Color fundus photograph · 2352x1568px.
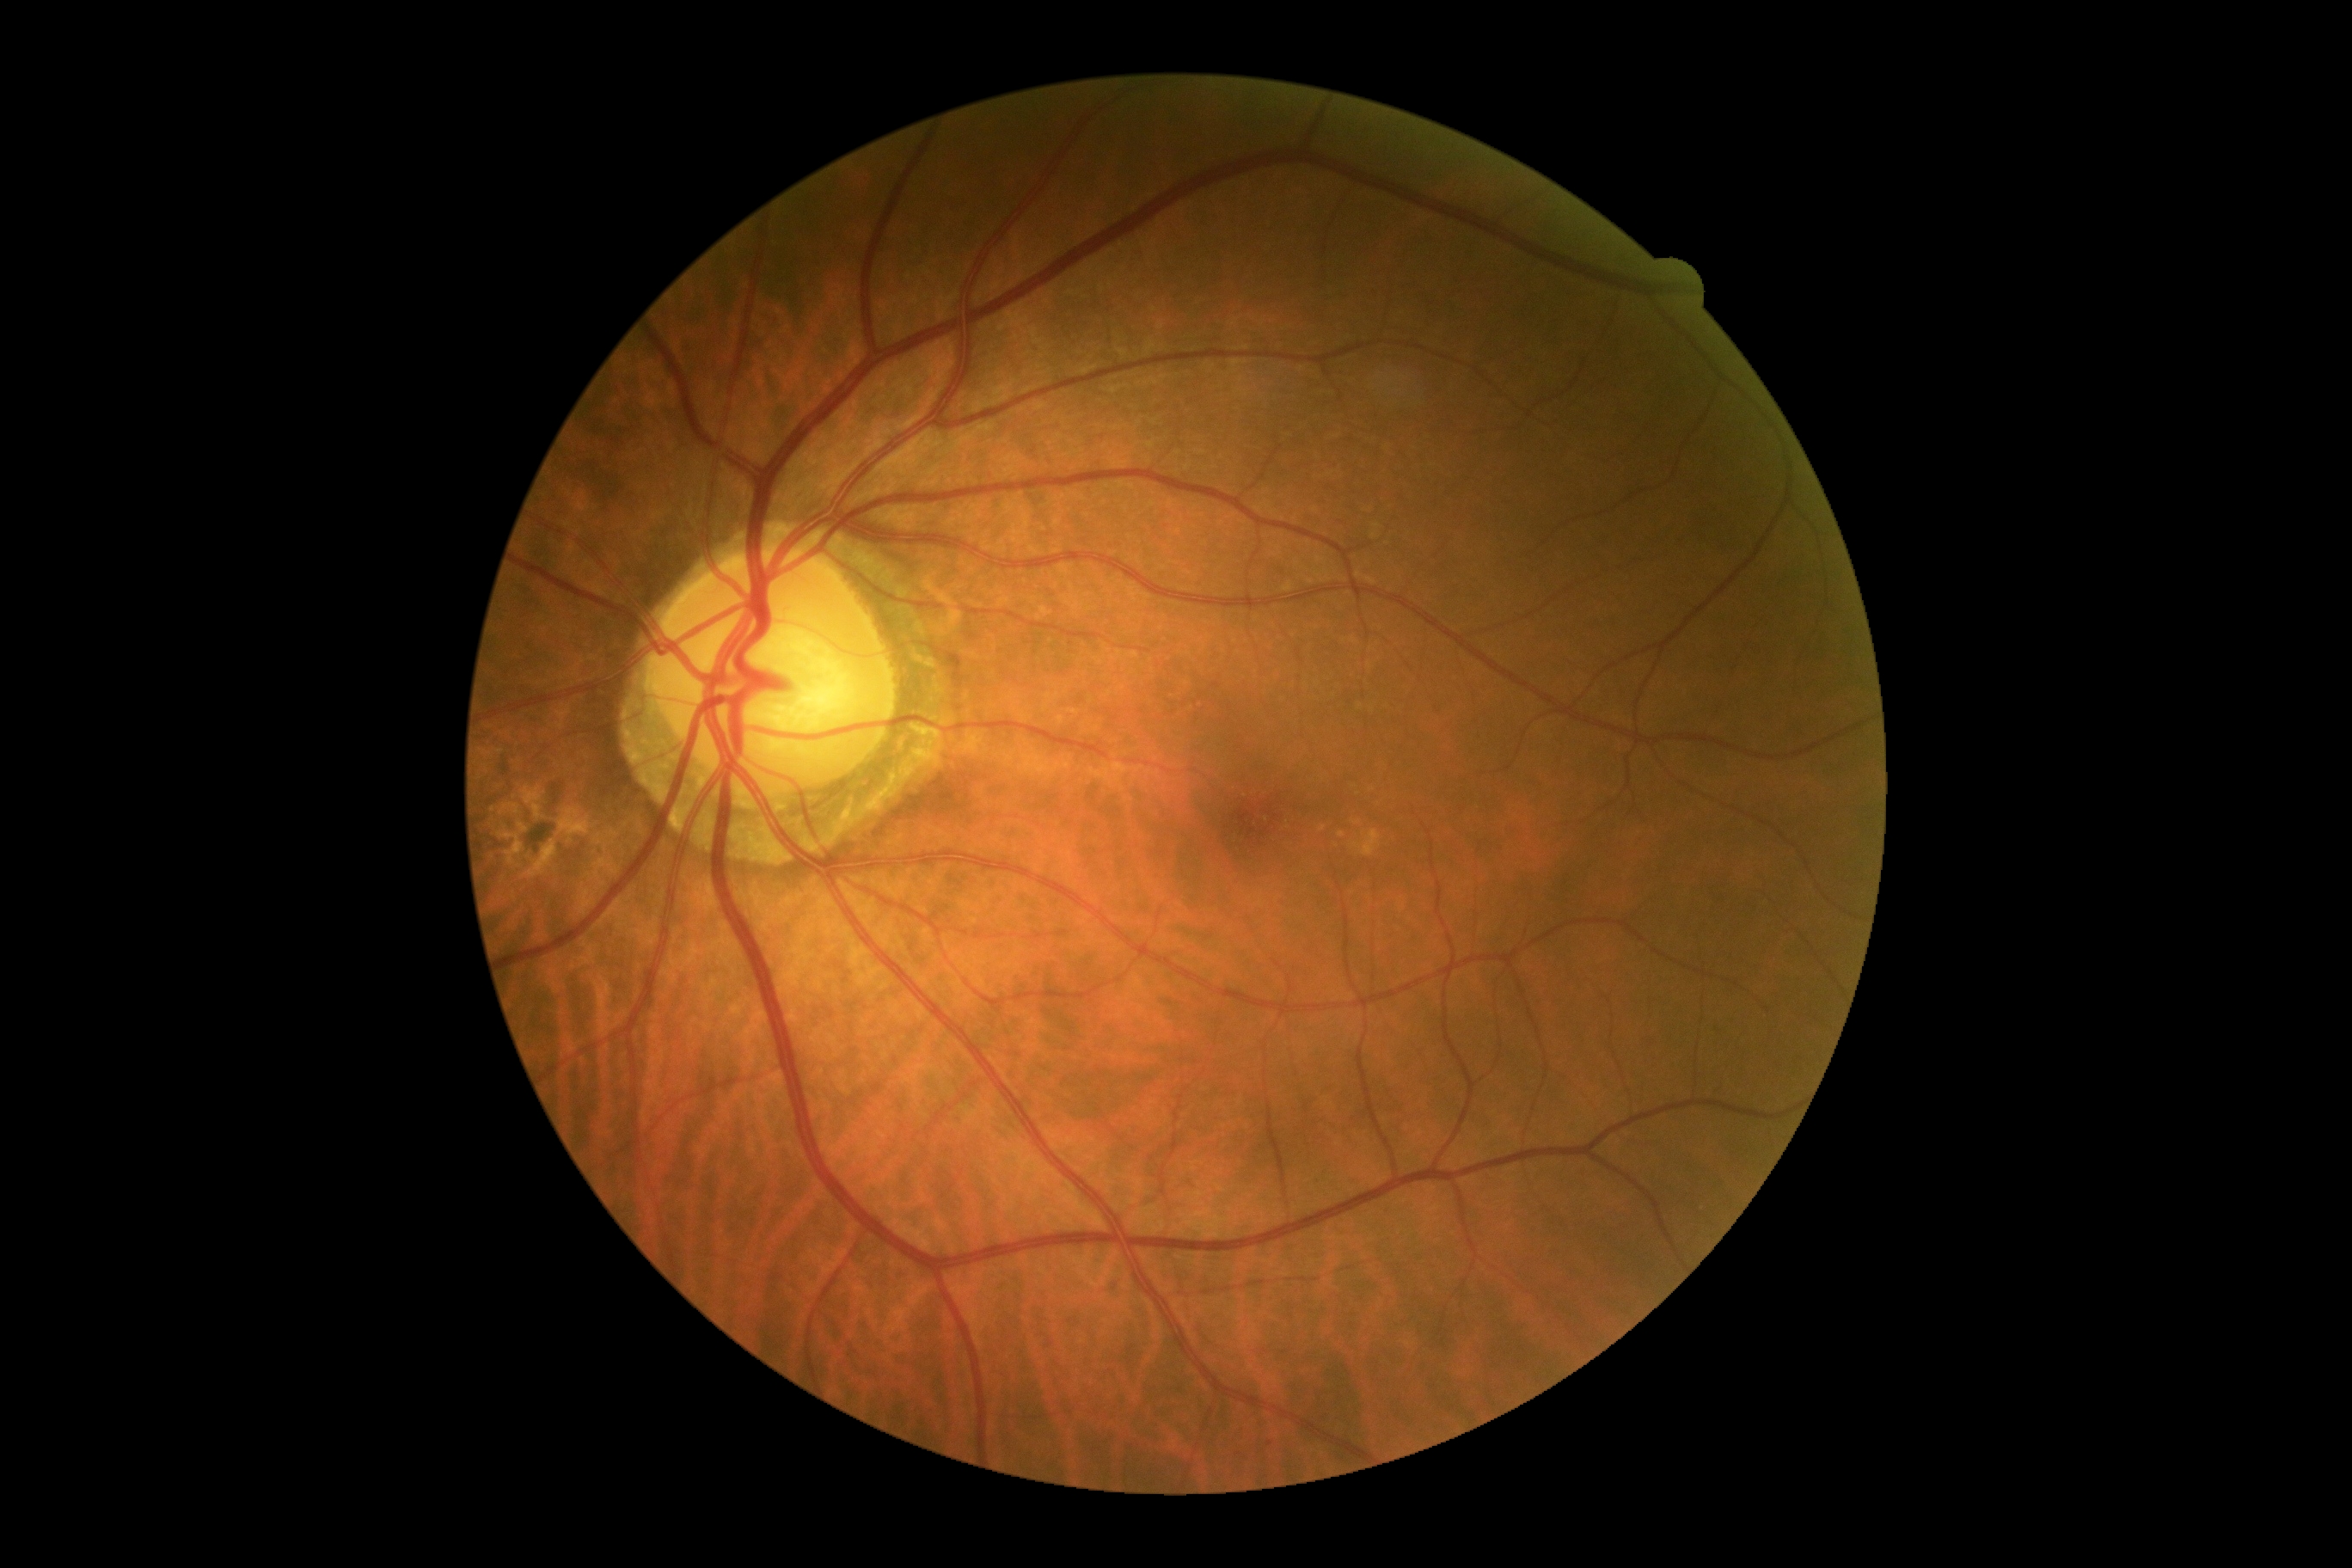

DR stage: 0/4.
No diabetic retinal disease findings.